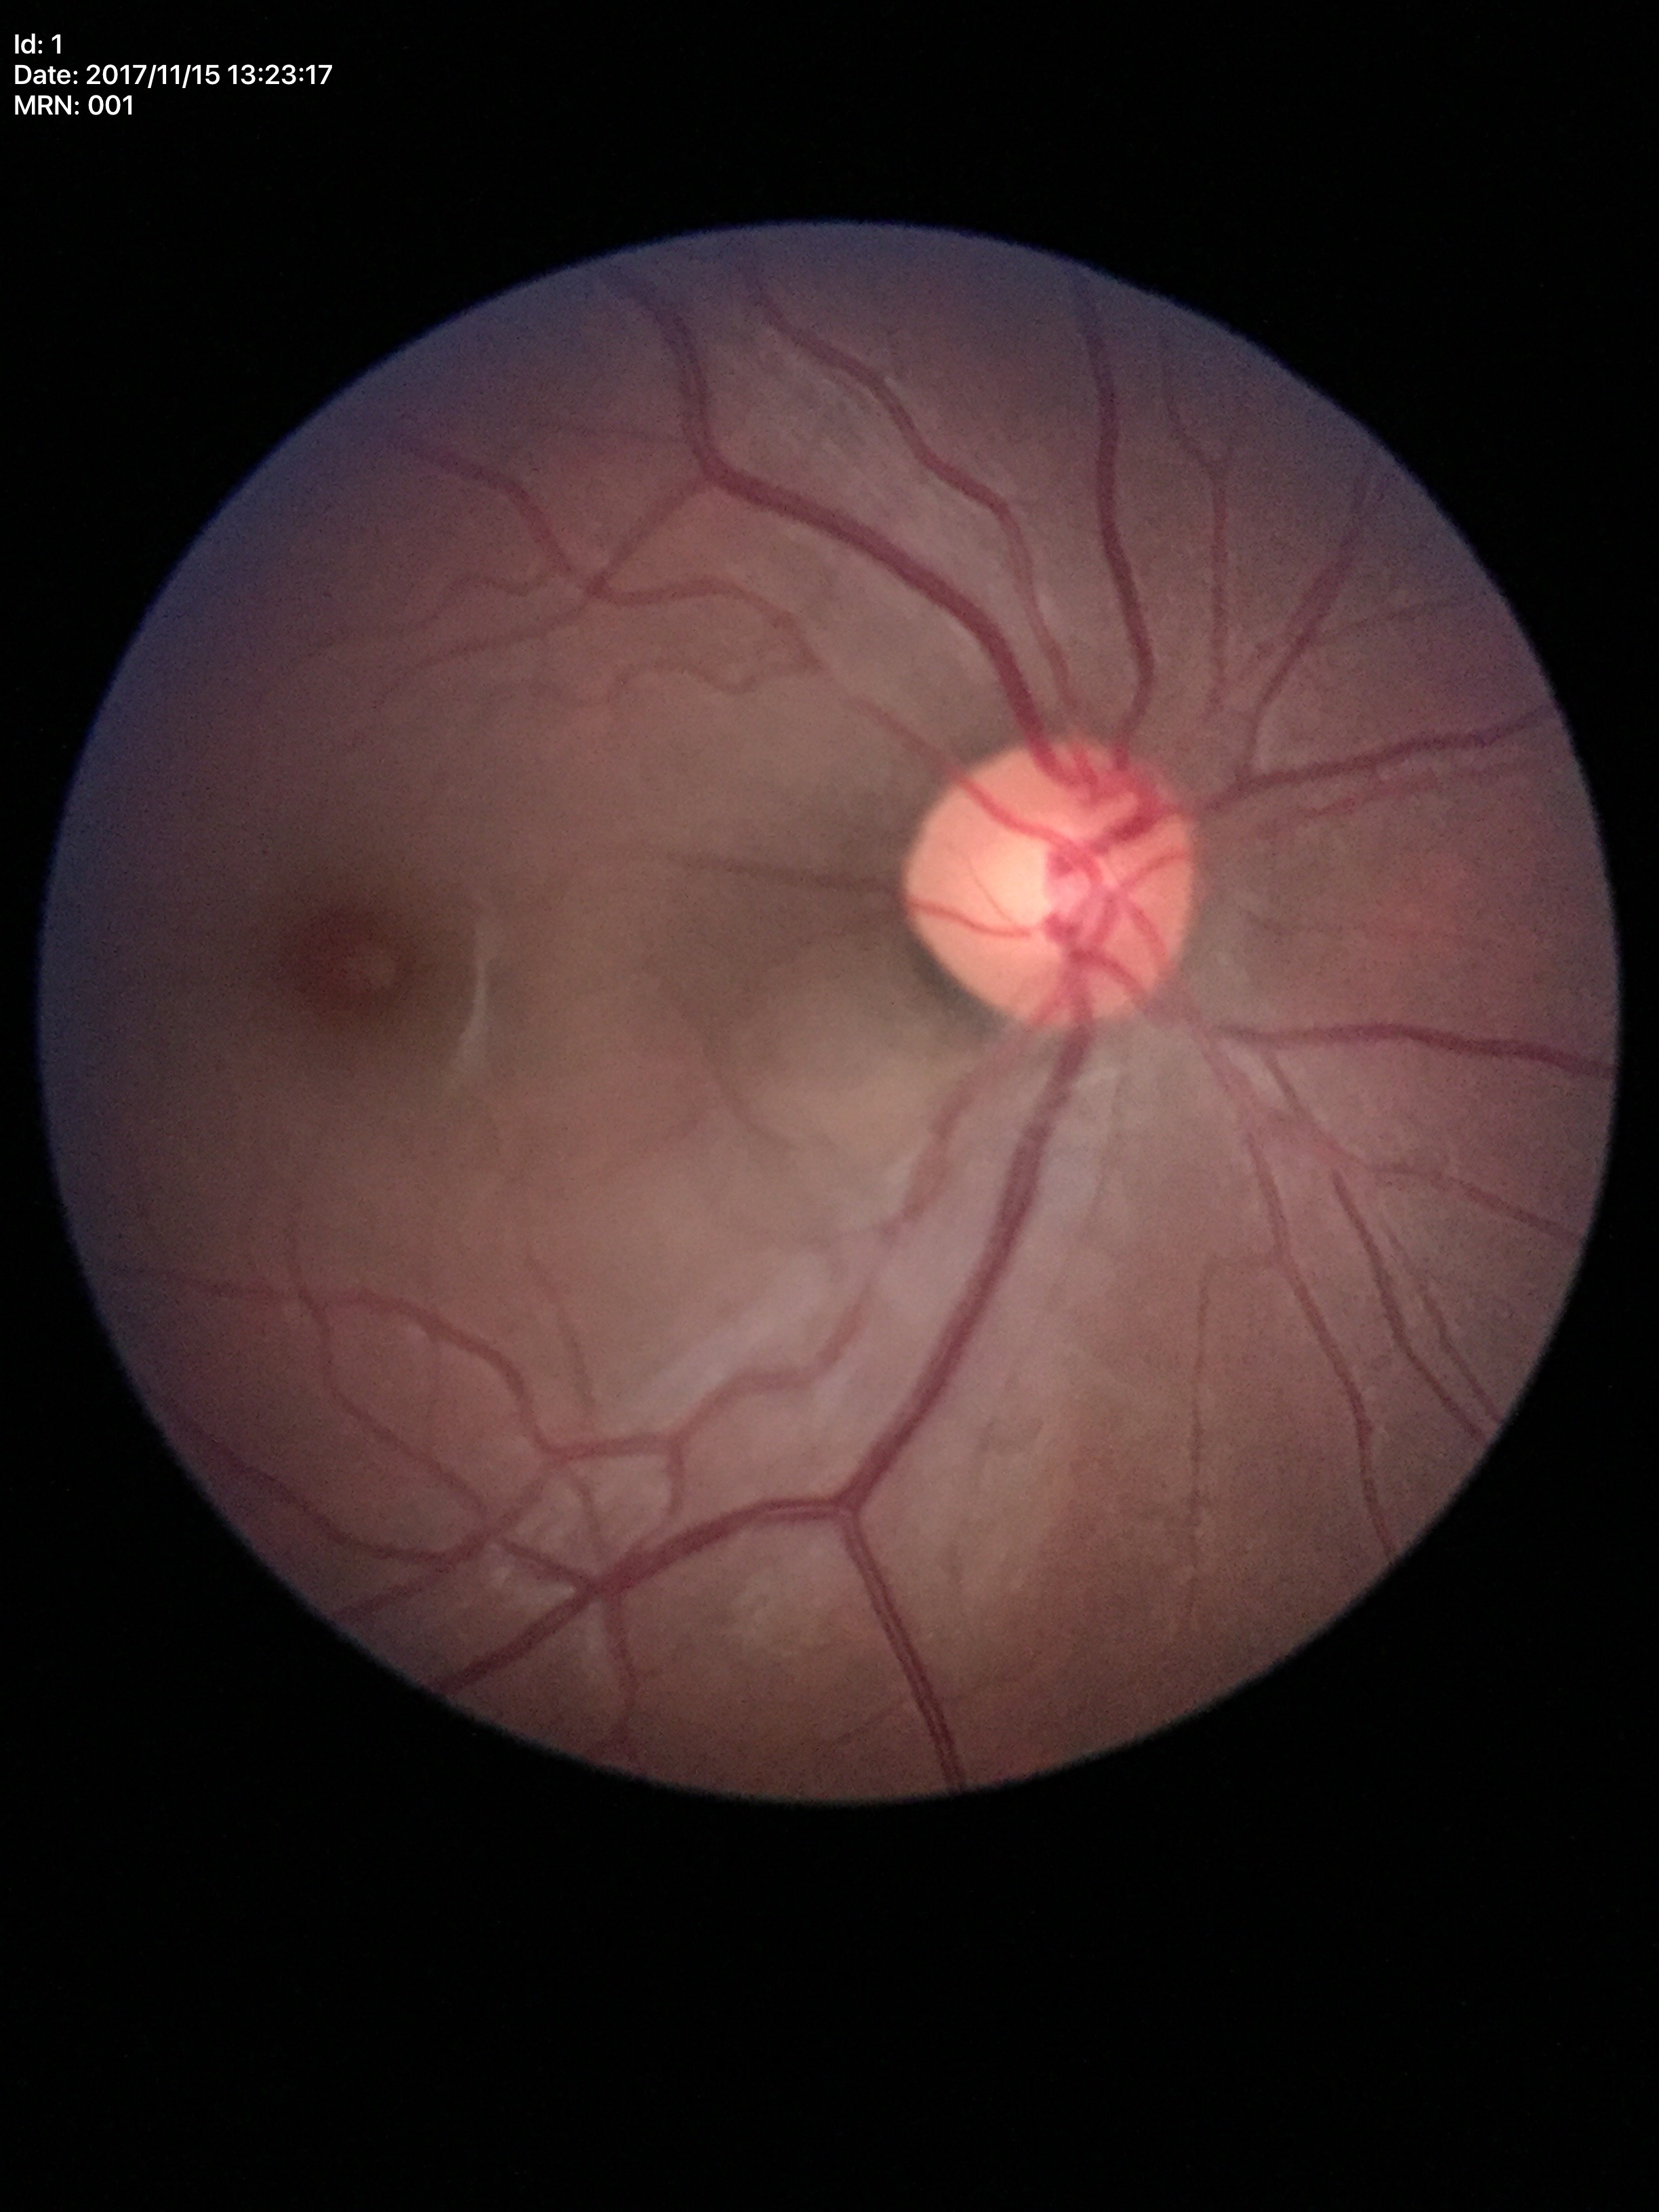 Vertical cup-to-disc ratio is 0.51. Horizontal CDR: 0.47. Area cup-to-disc ratio of 0.24. No glaucomatous optic neuropathy (5/5 ophthalmologists in agreement).